Image size 2212x1659; fundus photo:
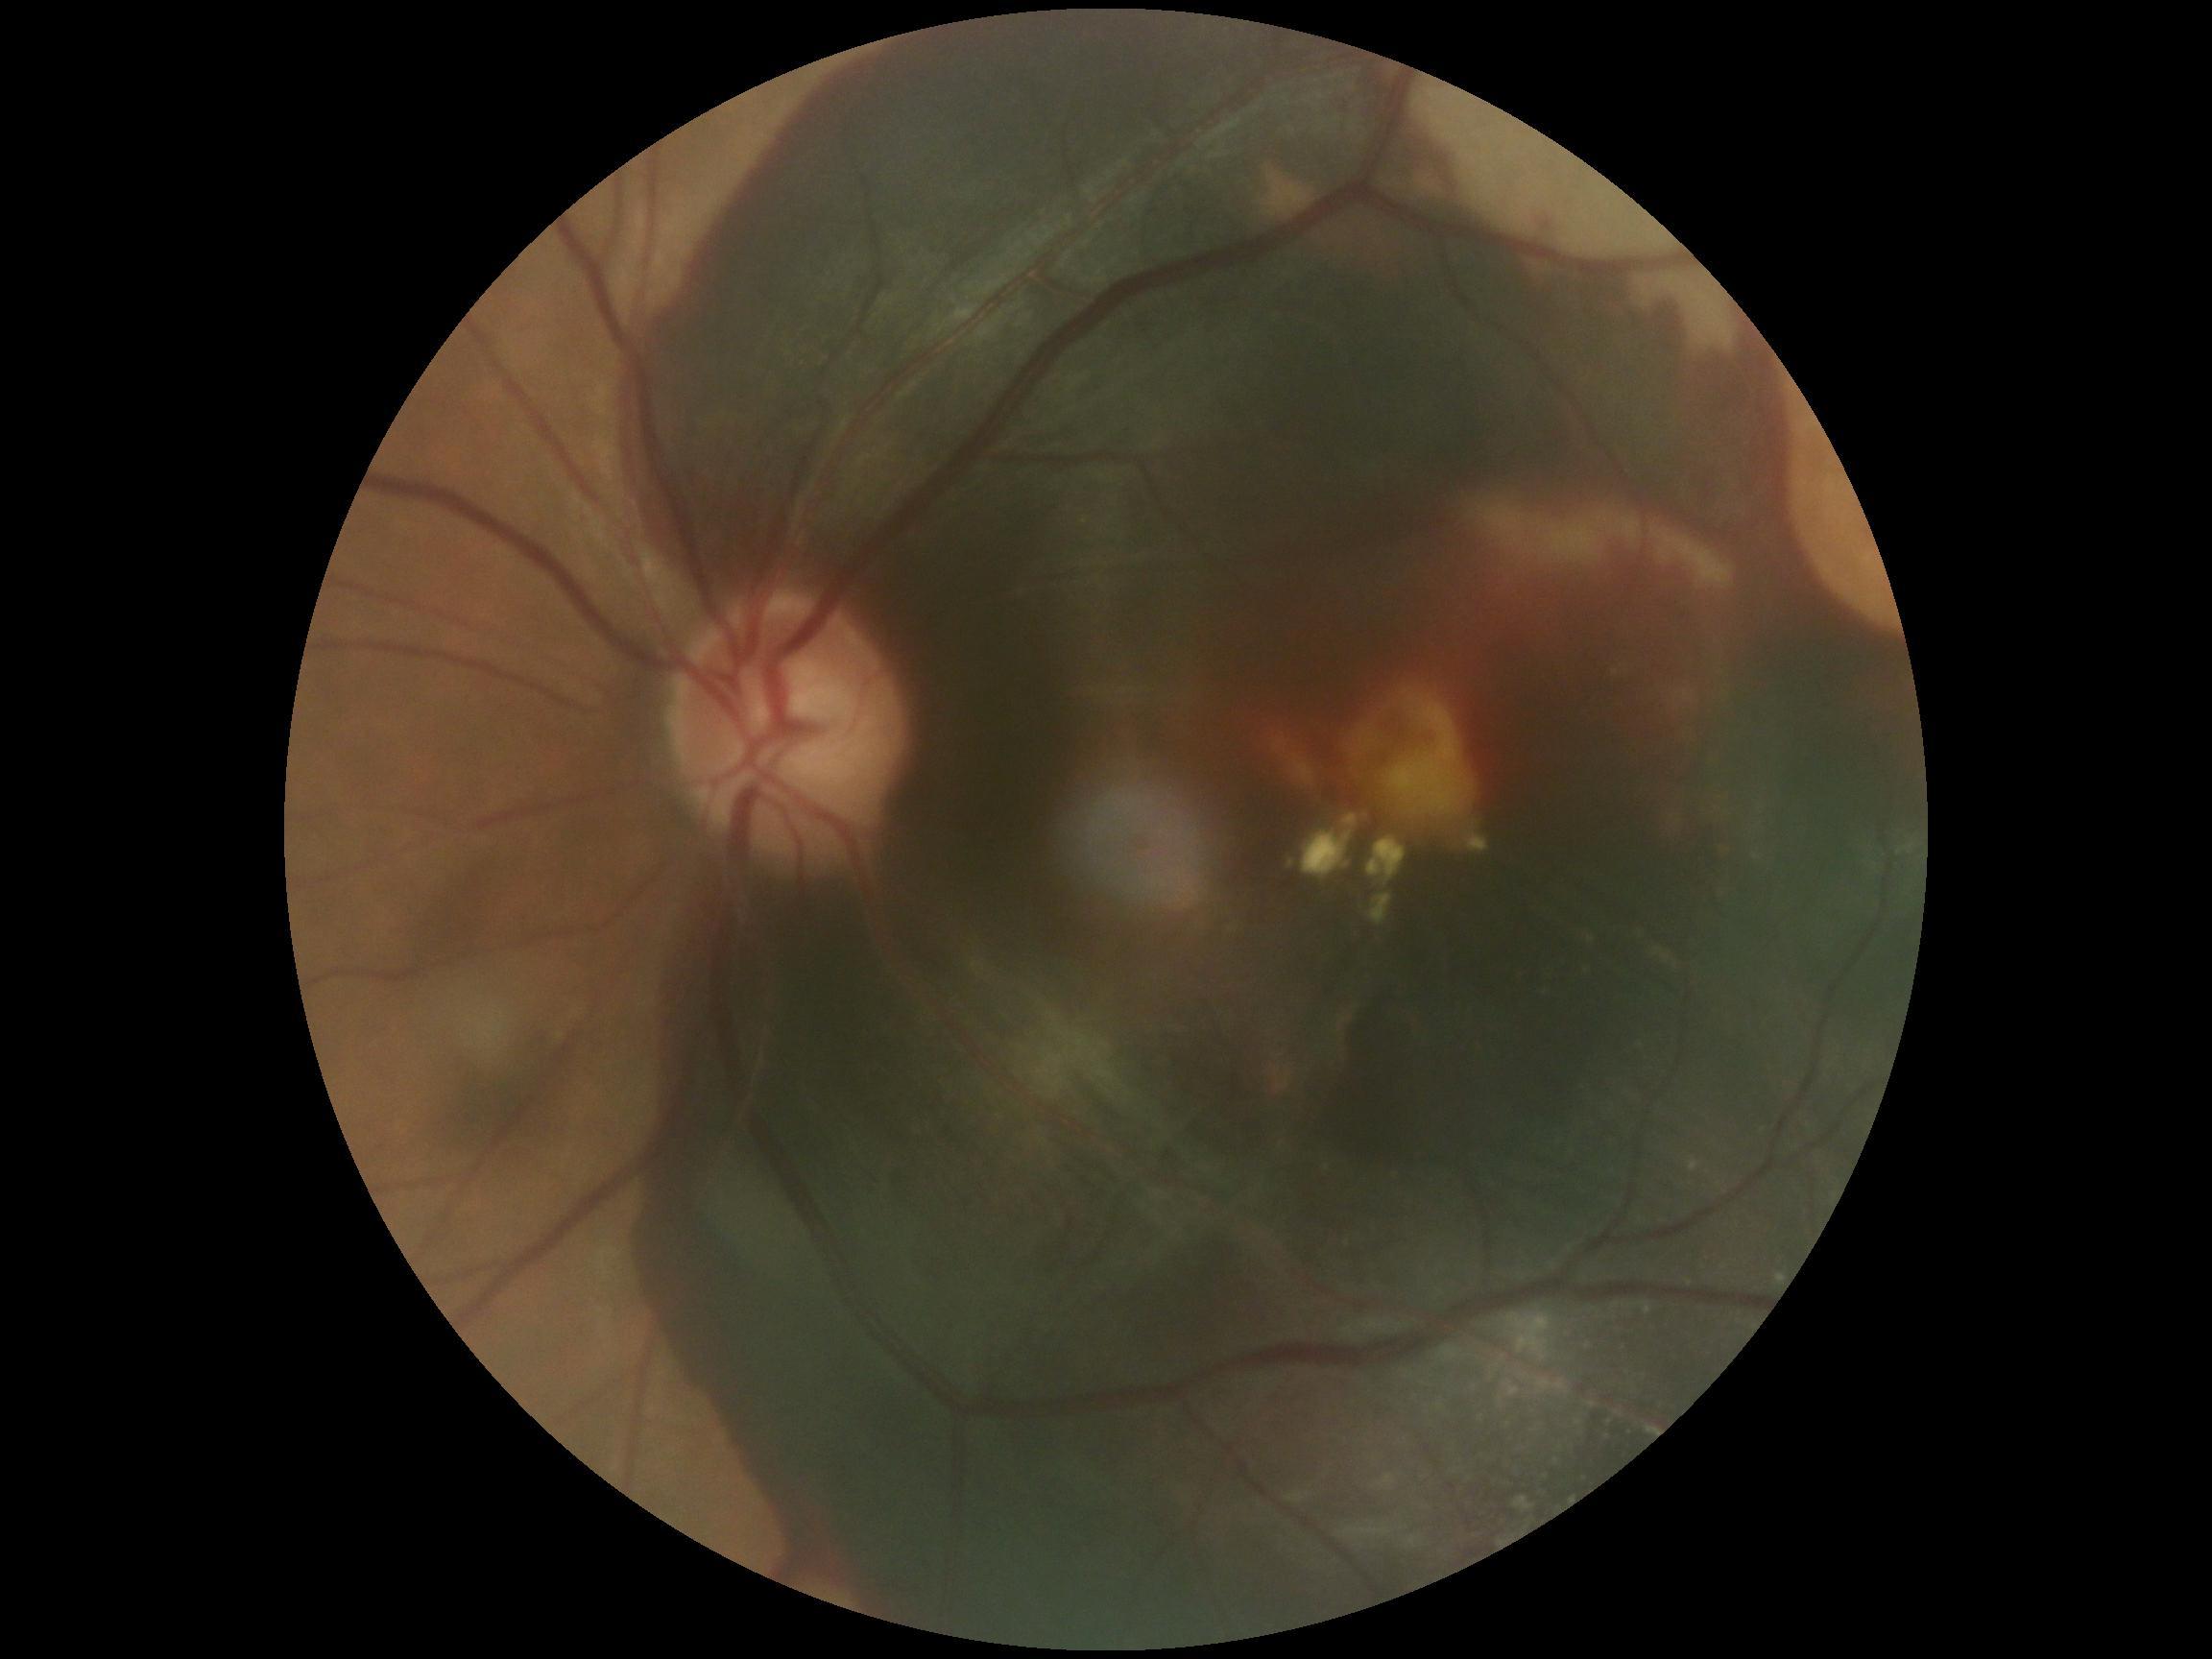
diabetic retinopathy (DR) = grade 4.